2184 x 1690 pixels.
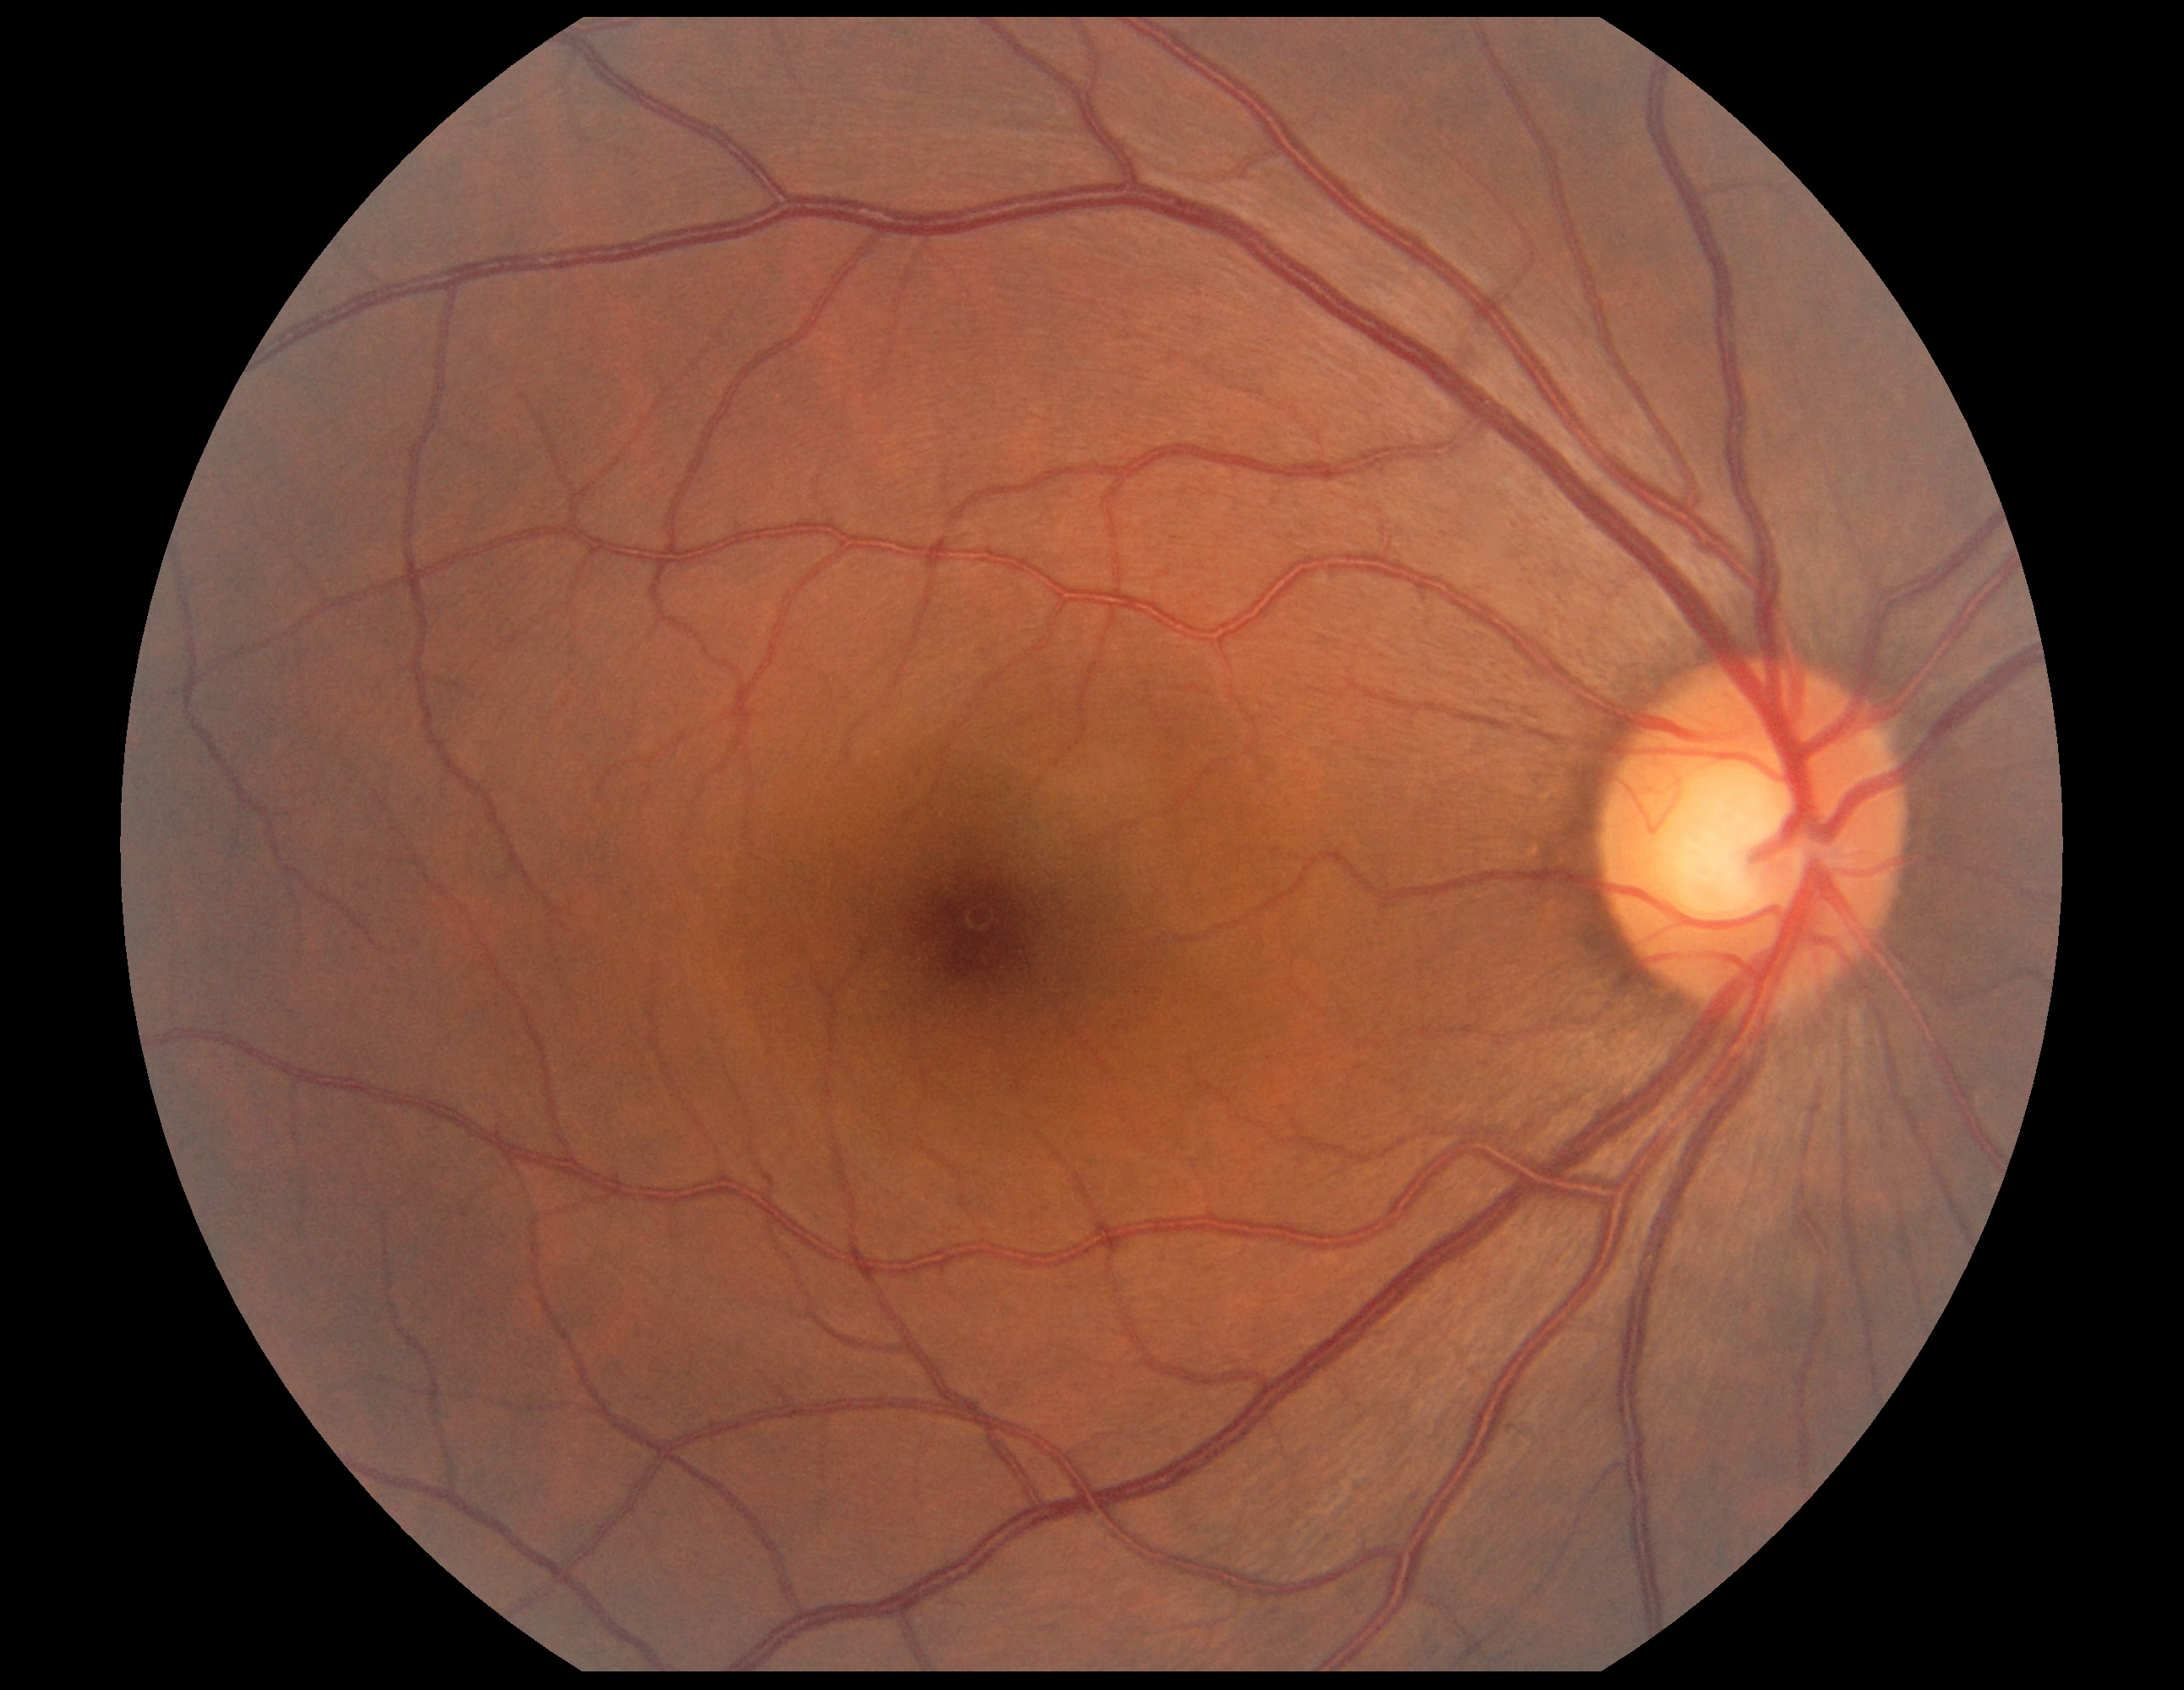 DR grade is no apparent retinopathy (0).